CFP — 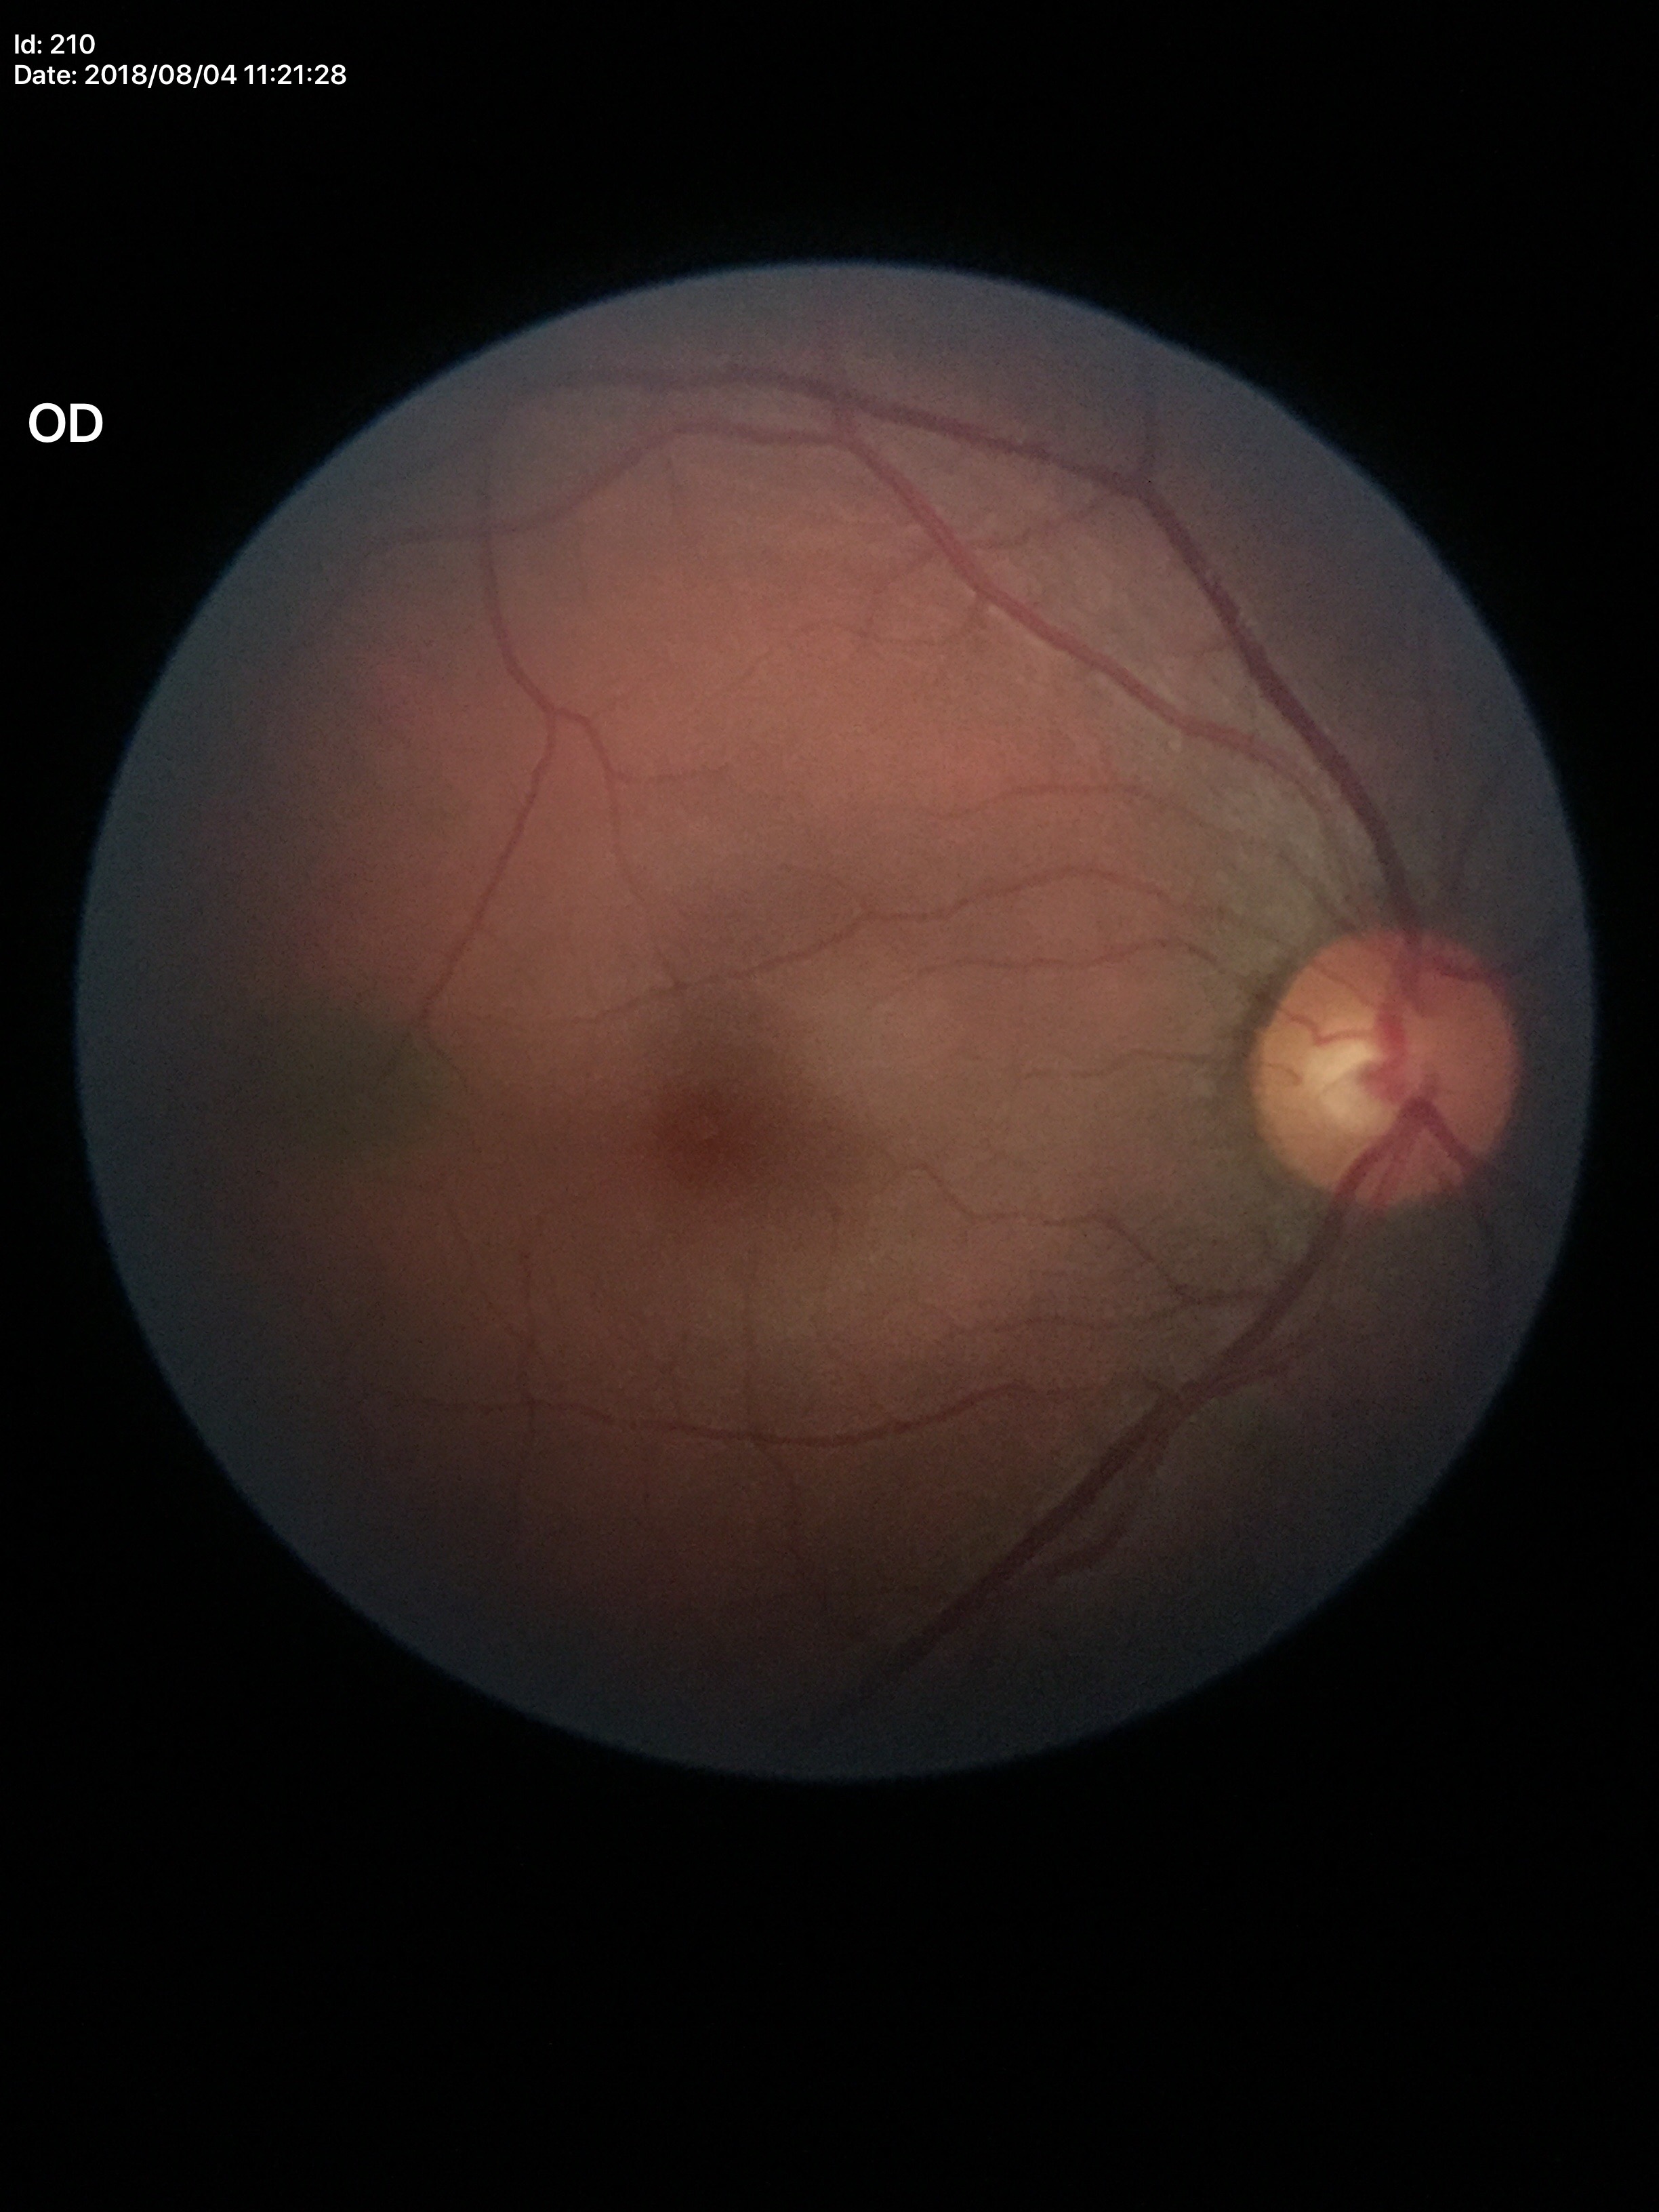

{"vcdr": "0.57", "glaucoma_decision": "no suspicious findings (2 of 5 graders flagged glaucoma suspect)"}